Wide-field fundus photograph of an infant; 1240 x 1240 pixels; 100° field of view (Phoenix ICON):
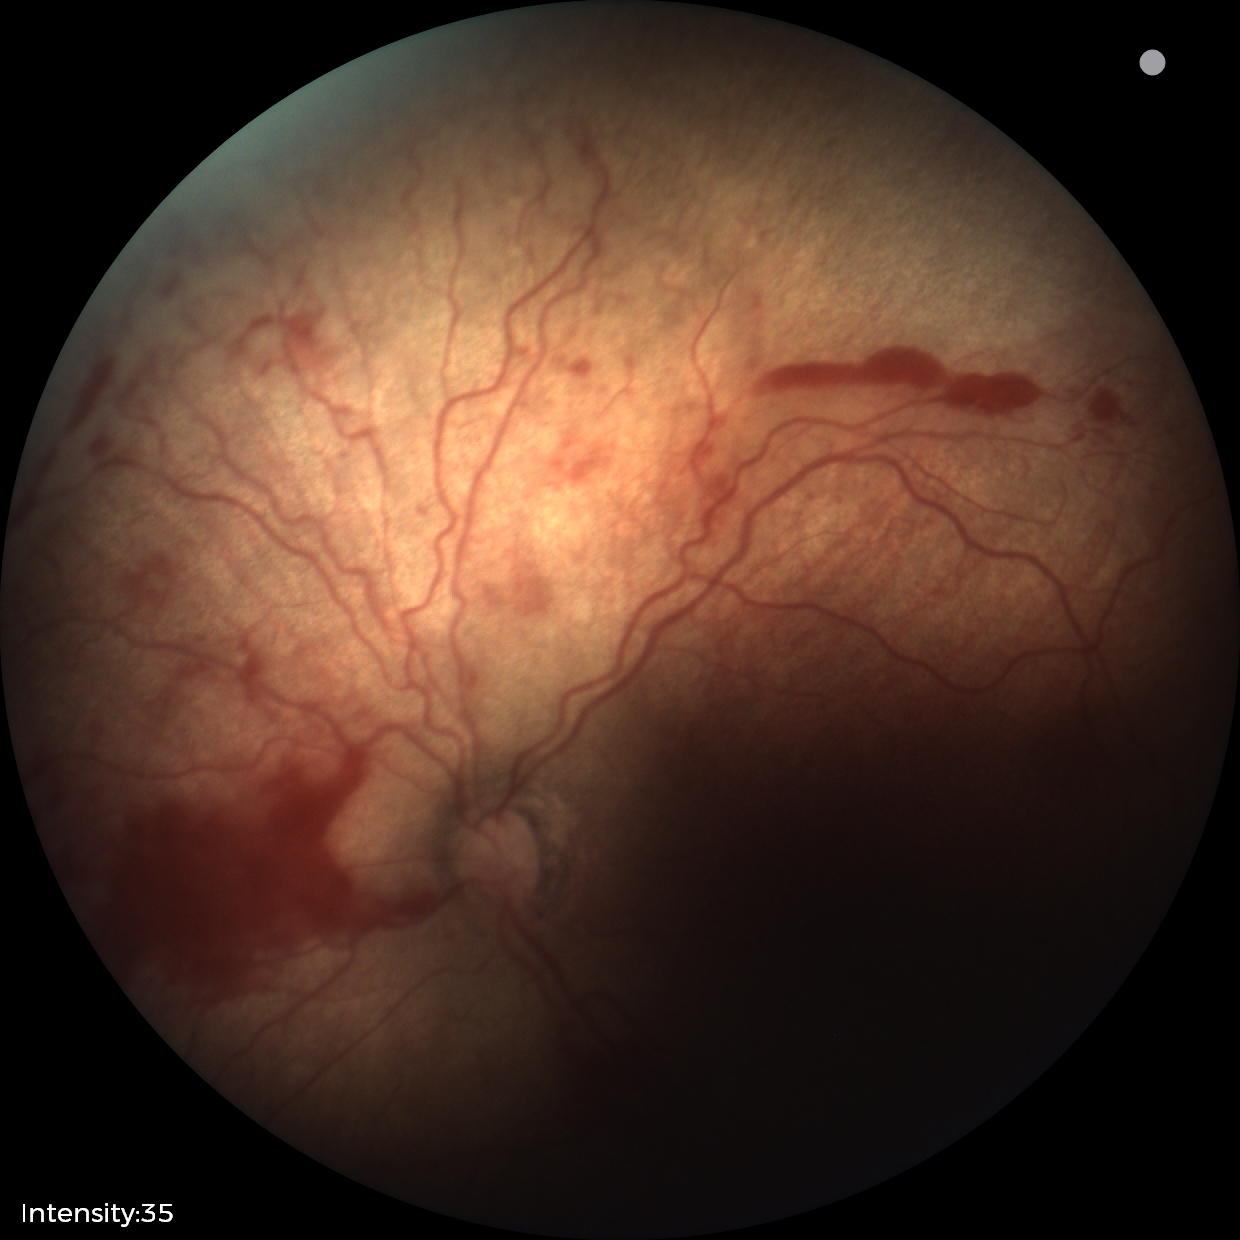
Diagnosis from this screening exam: ROP stage 2.